45° field of view, 2346 by 1568 pixels: 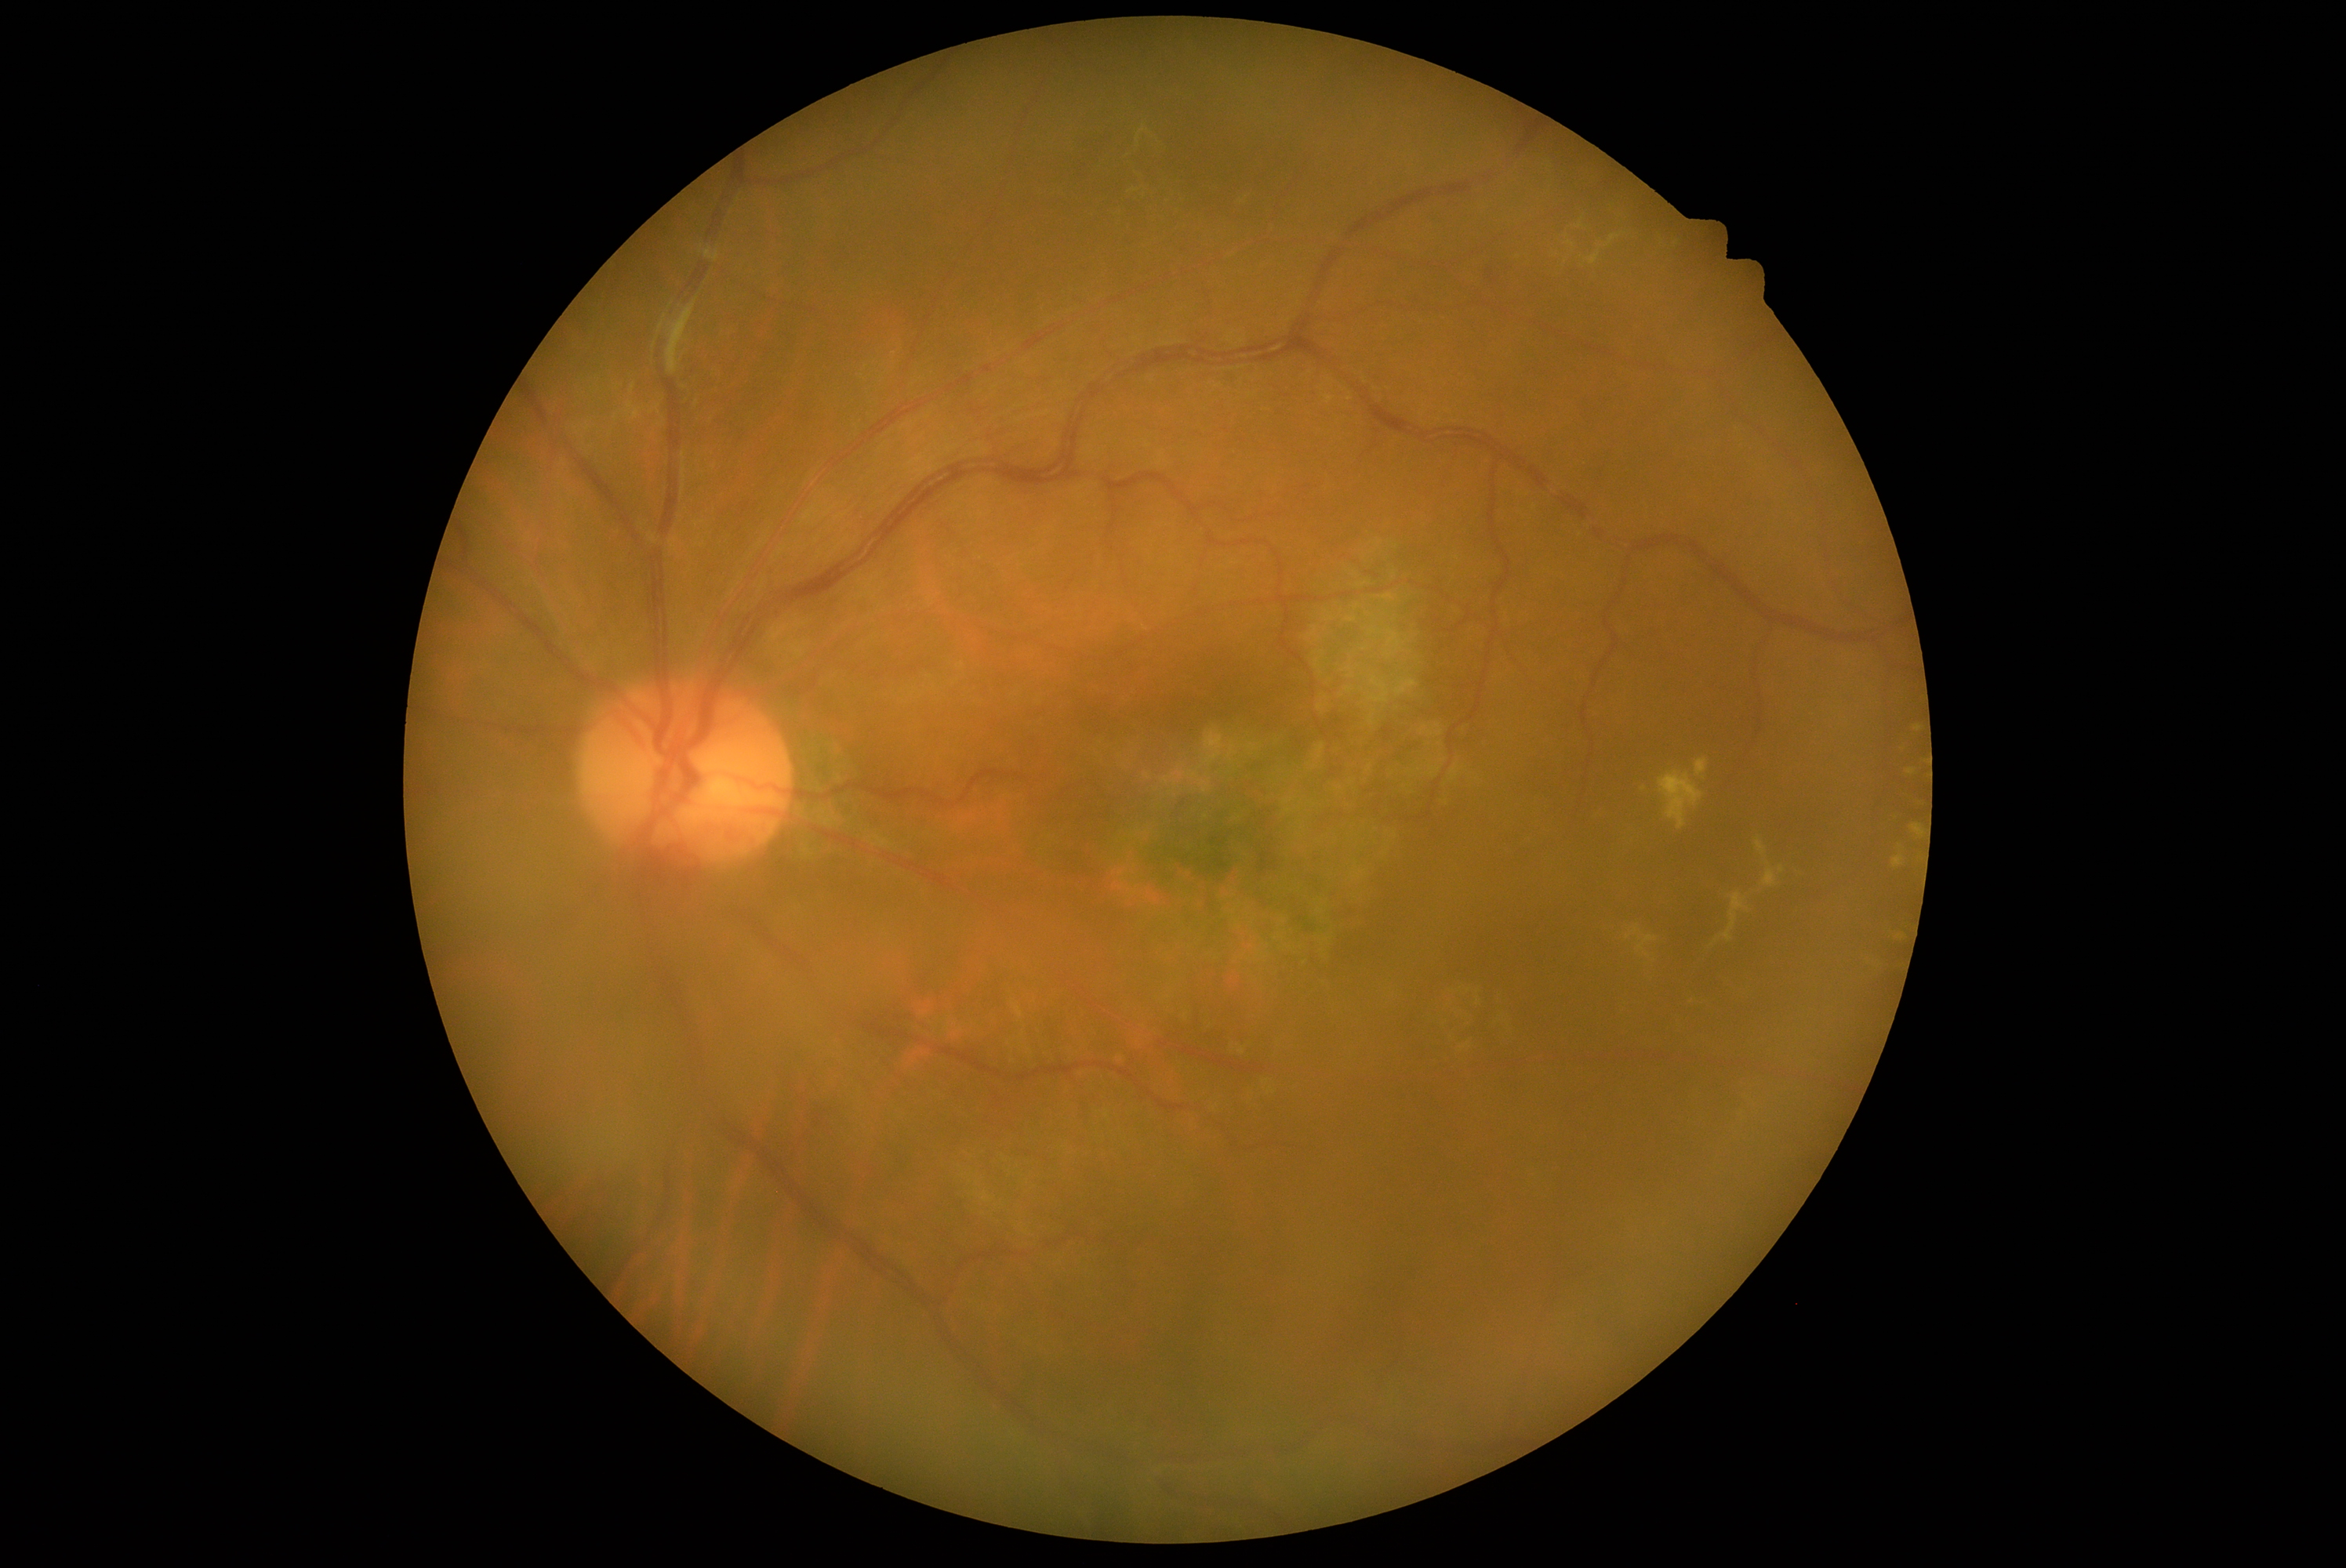 DR severity: 2. Disease class: non-proliferative diabetic retinopathy.